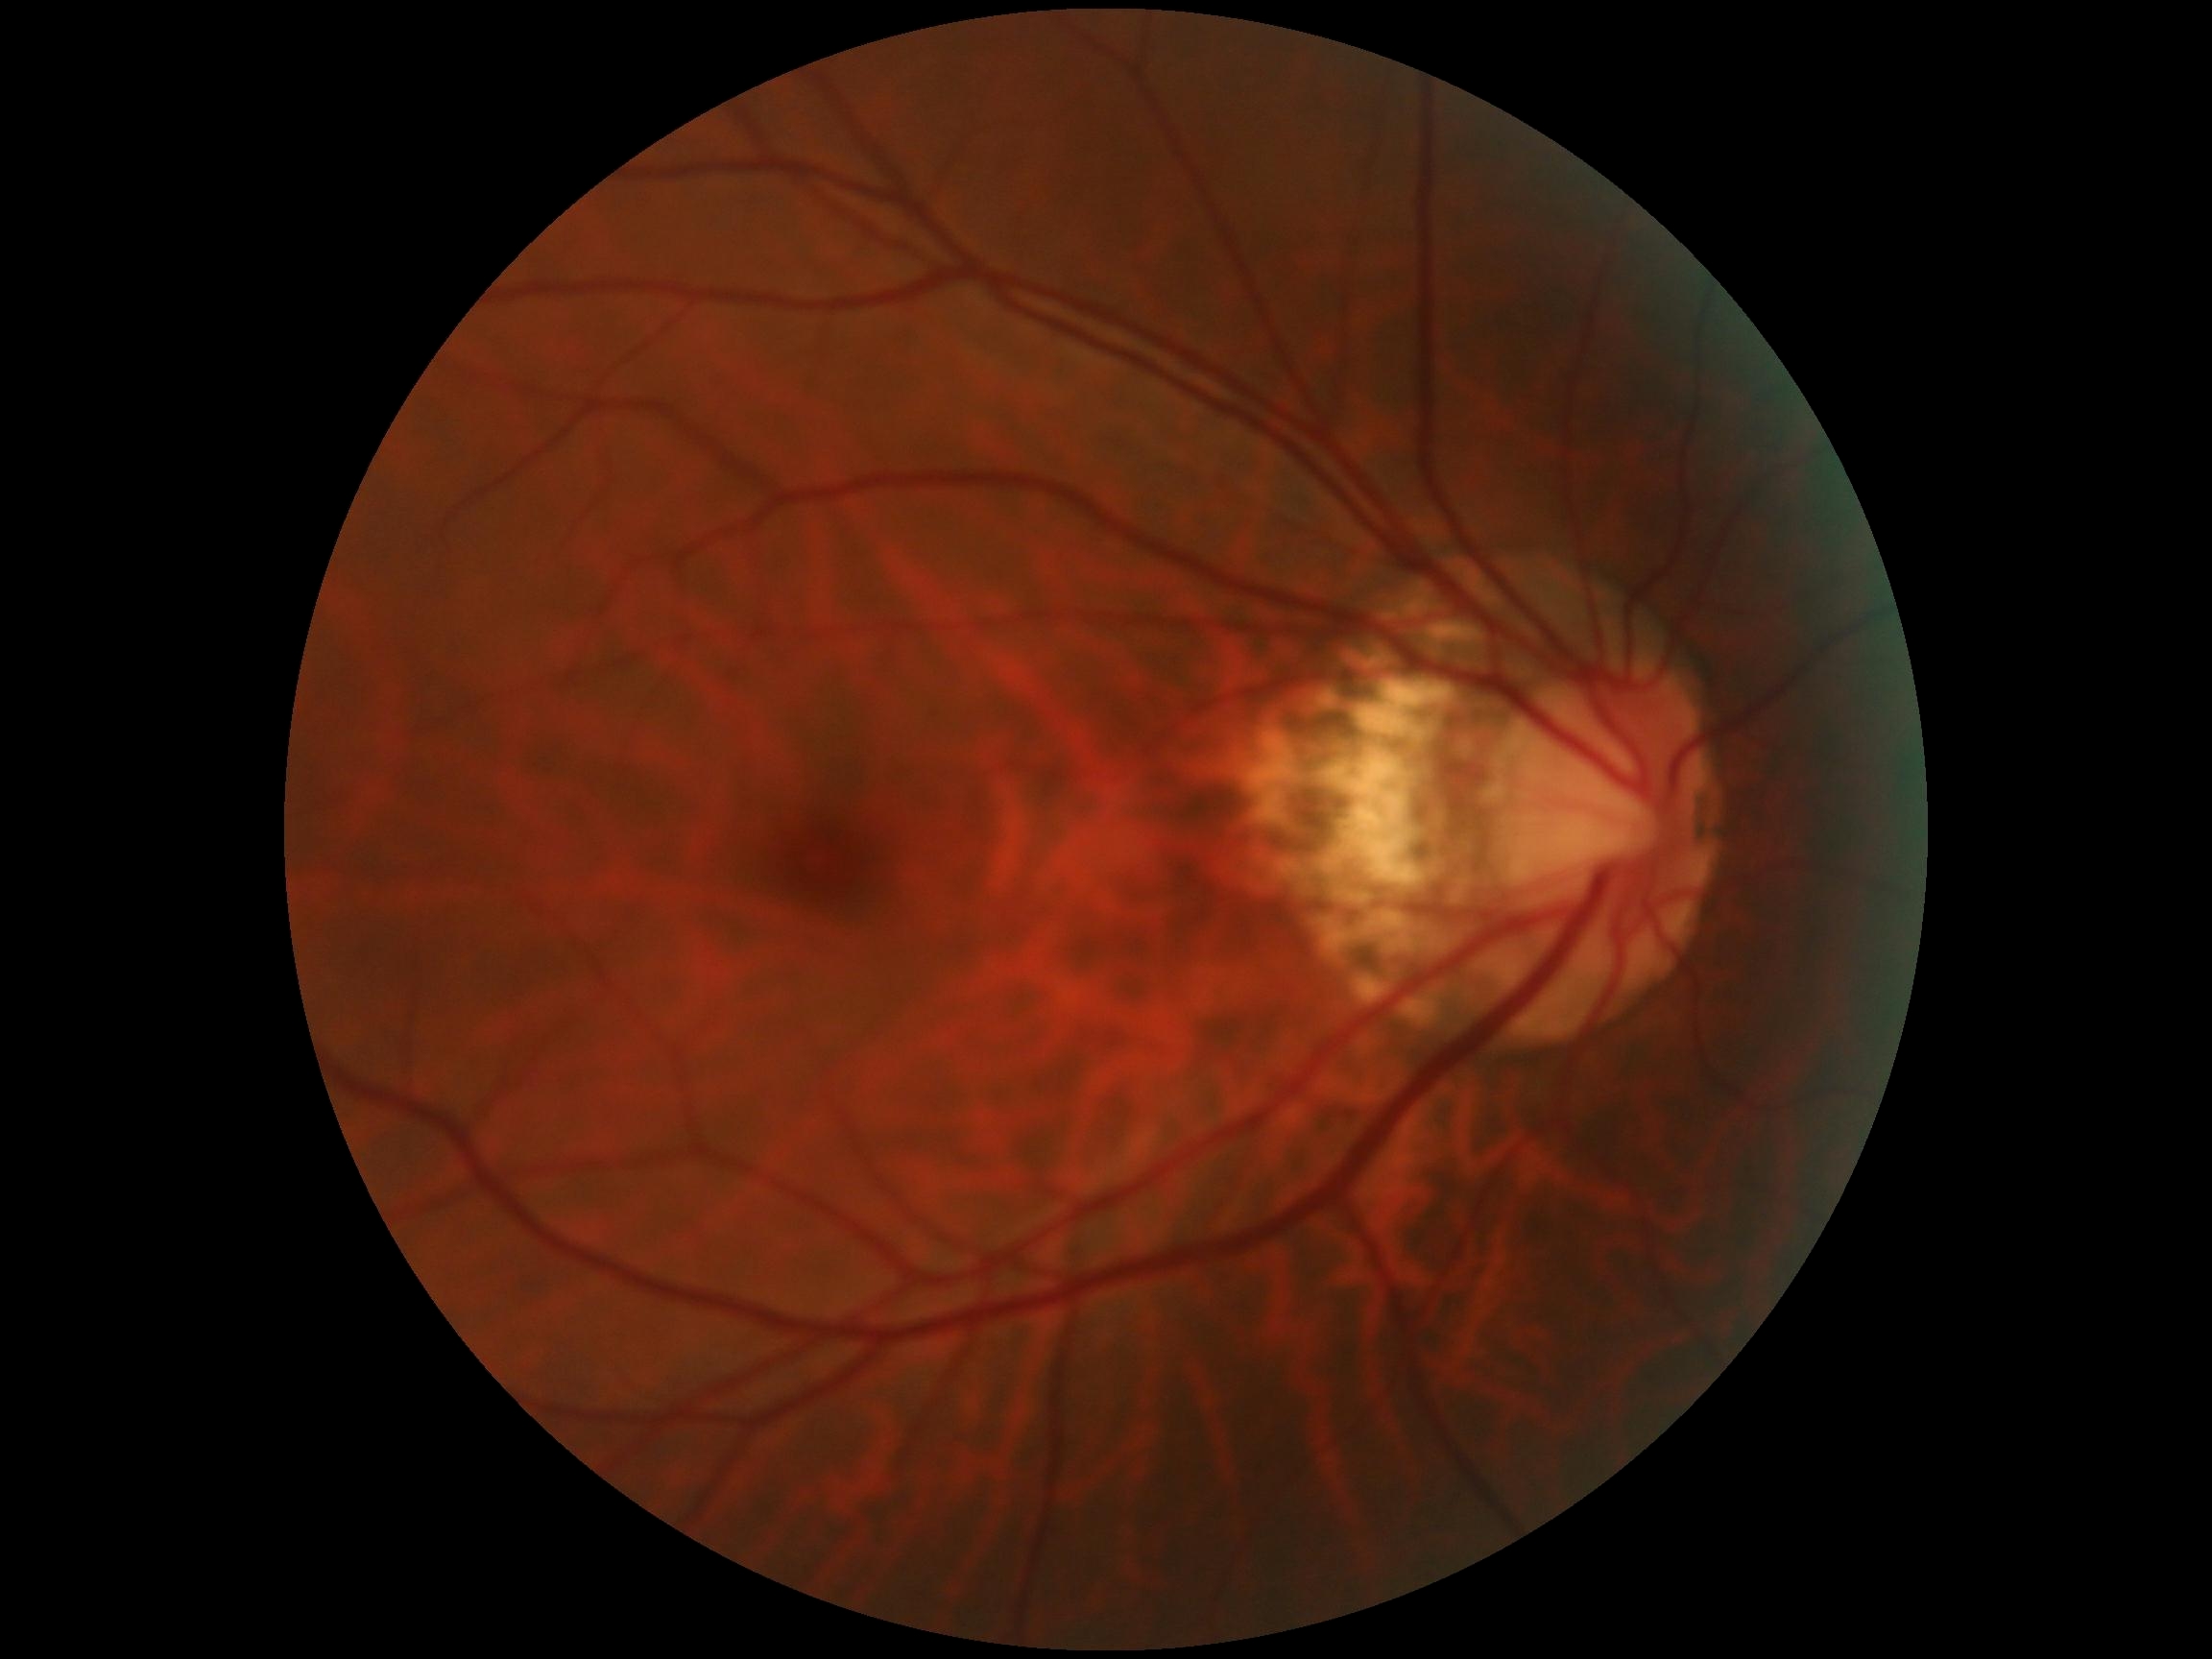 DR grade: 0.